Color fundus photograph; captured on a Remidio smartphone fundus camera; 1659x2212px
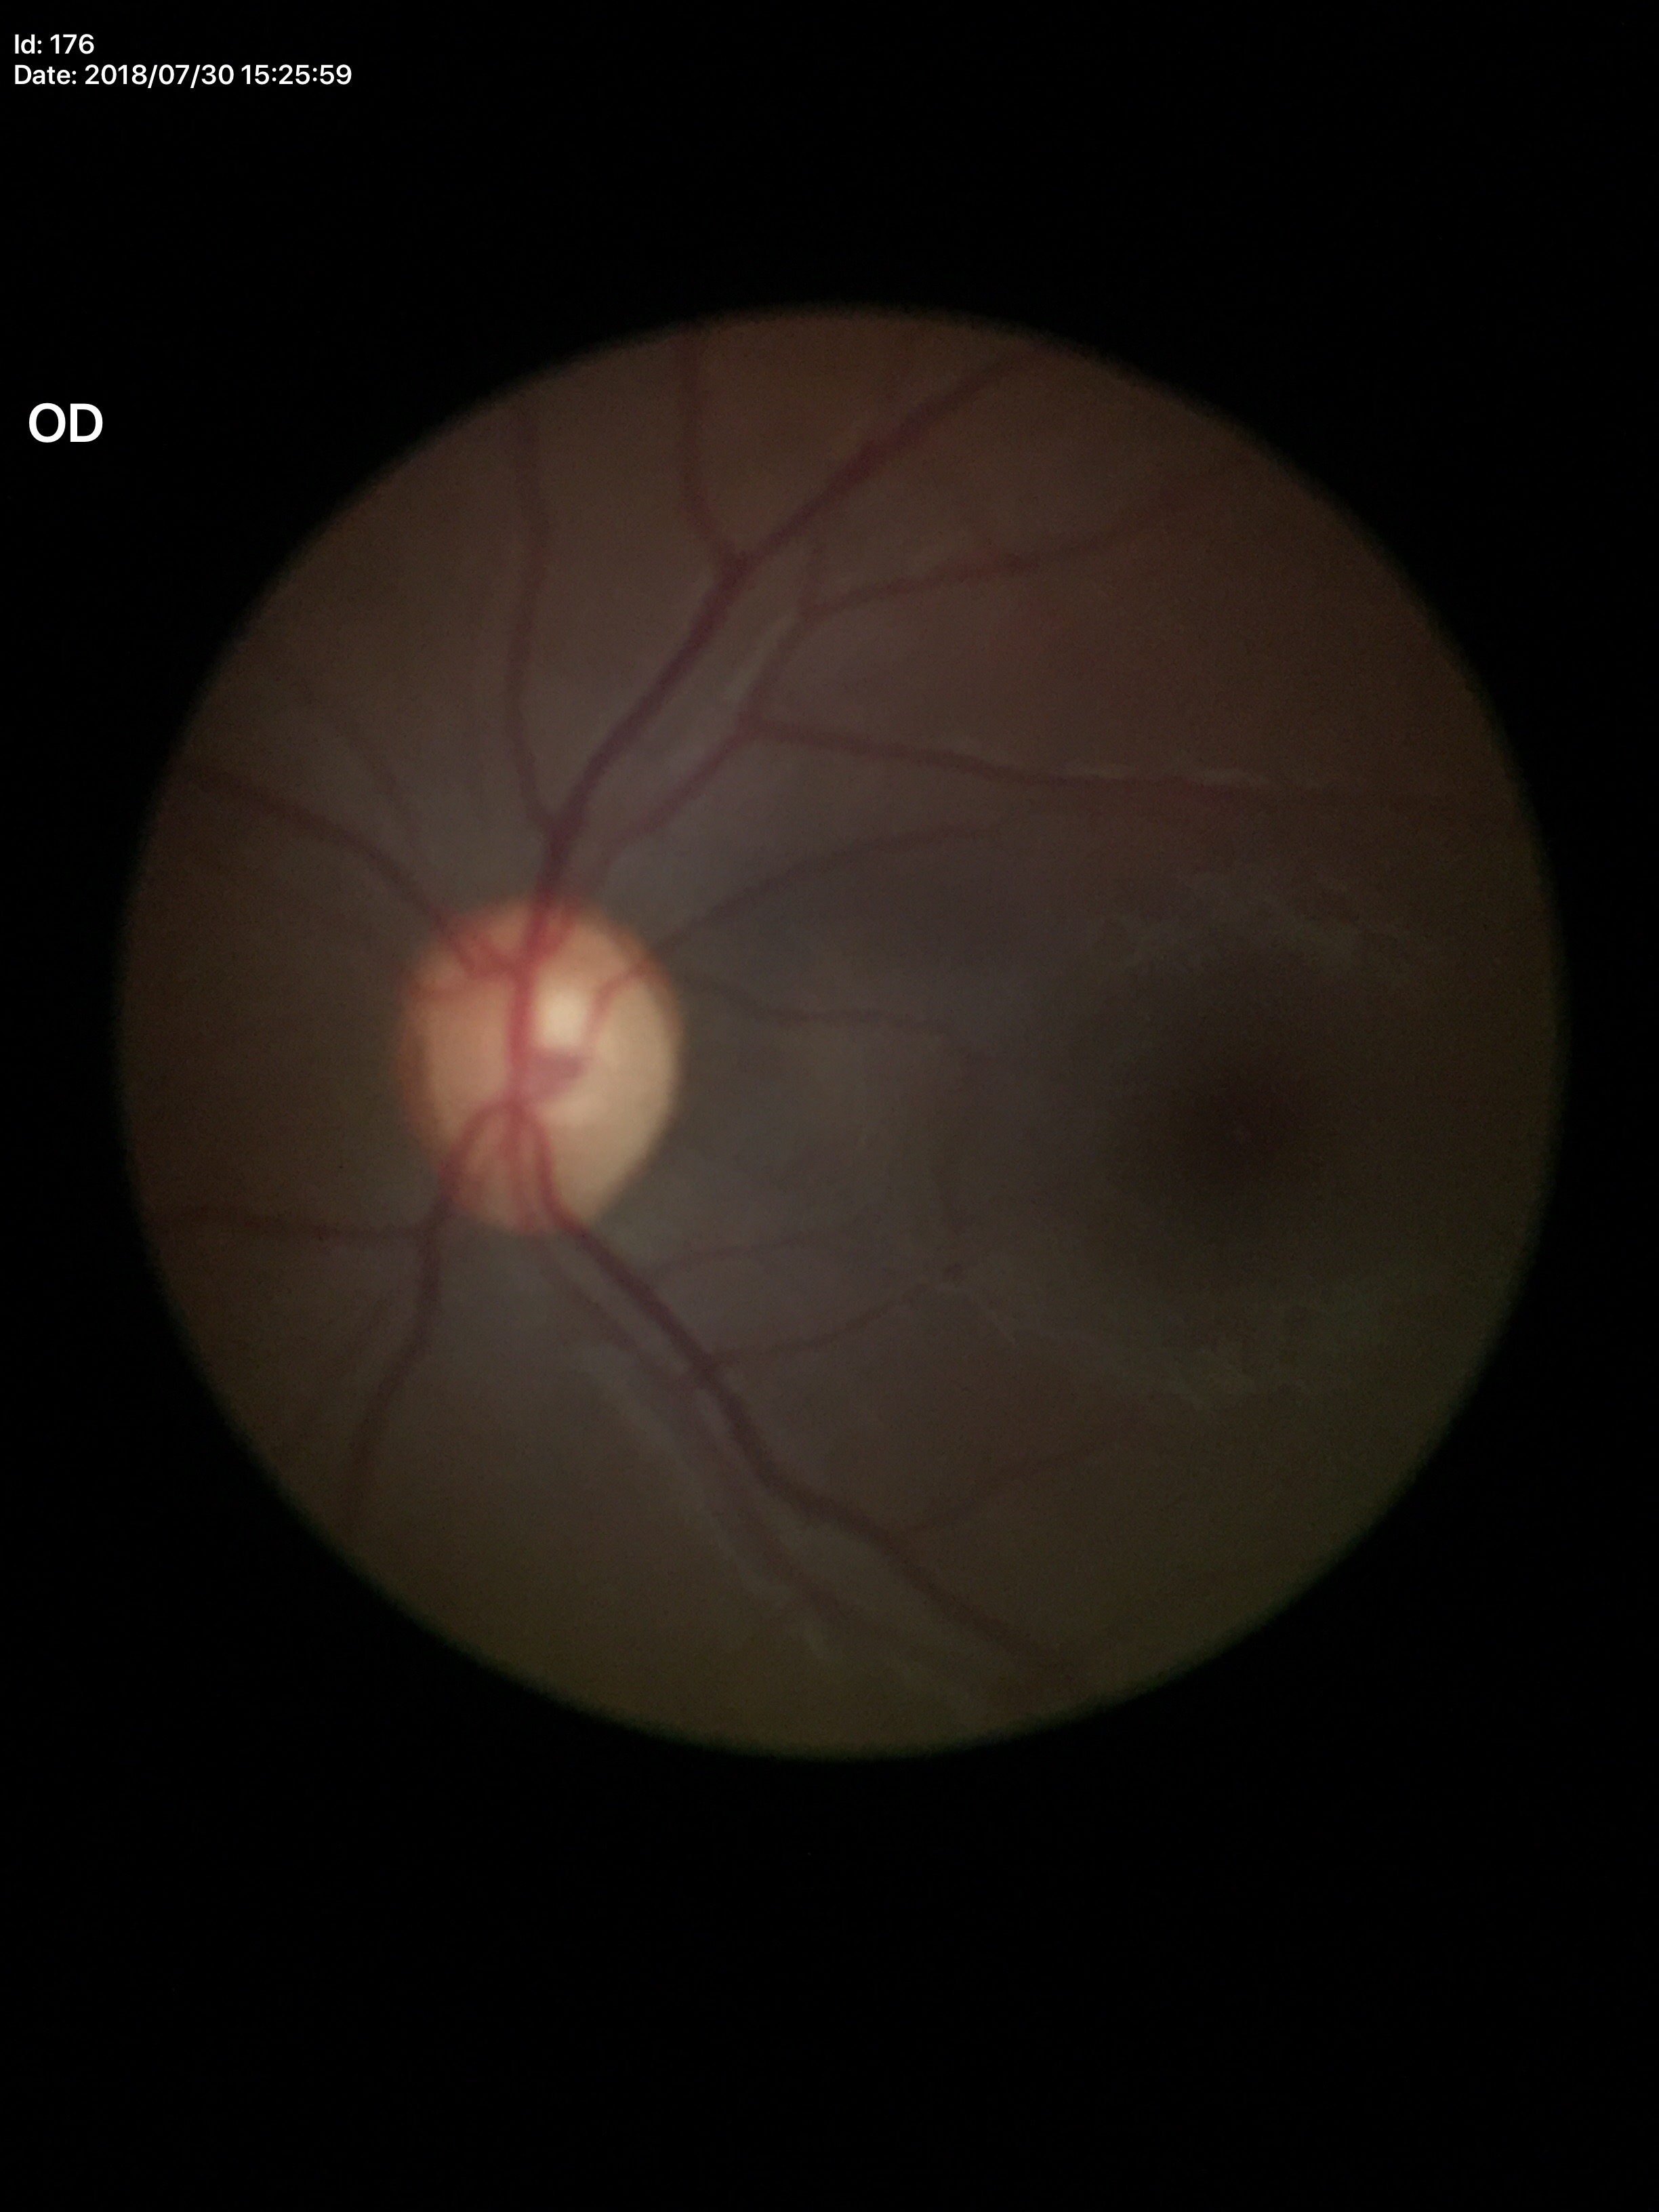
Glaucoma evaluation: not suspect | vertical C/D ratio (VCDR): 0.56 | area CDR (ACDR): 0.30.